Color fundus image, 1932x1932
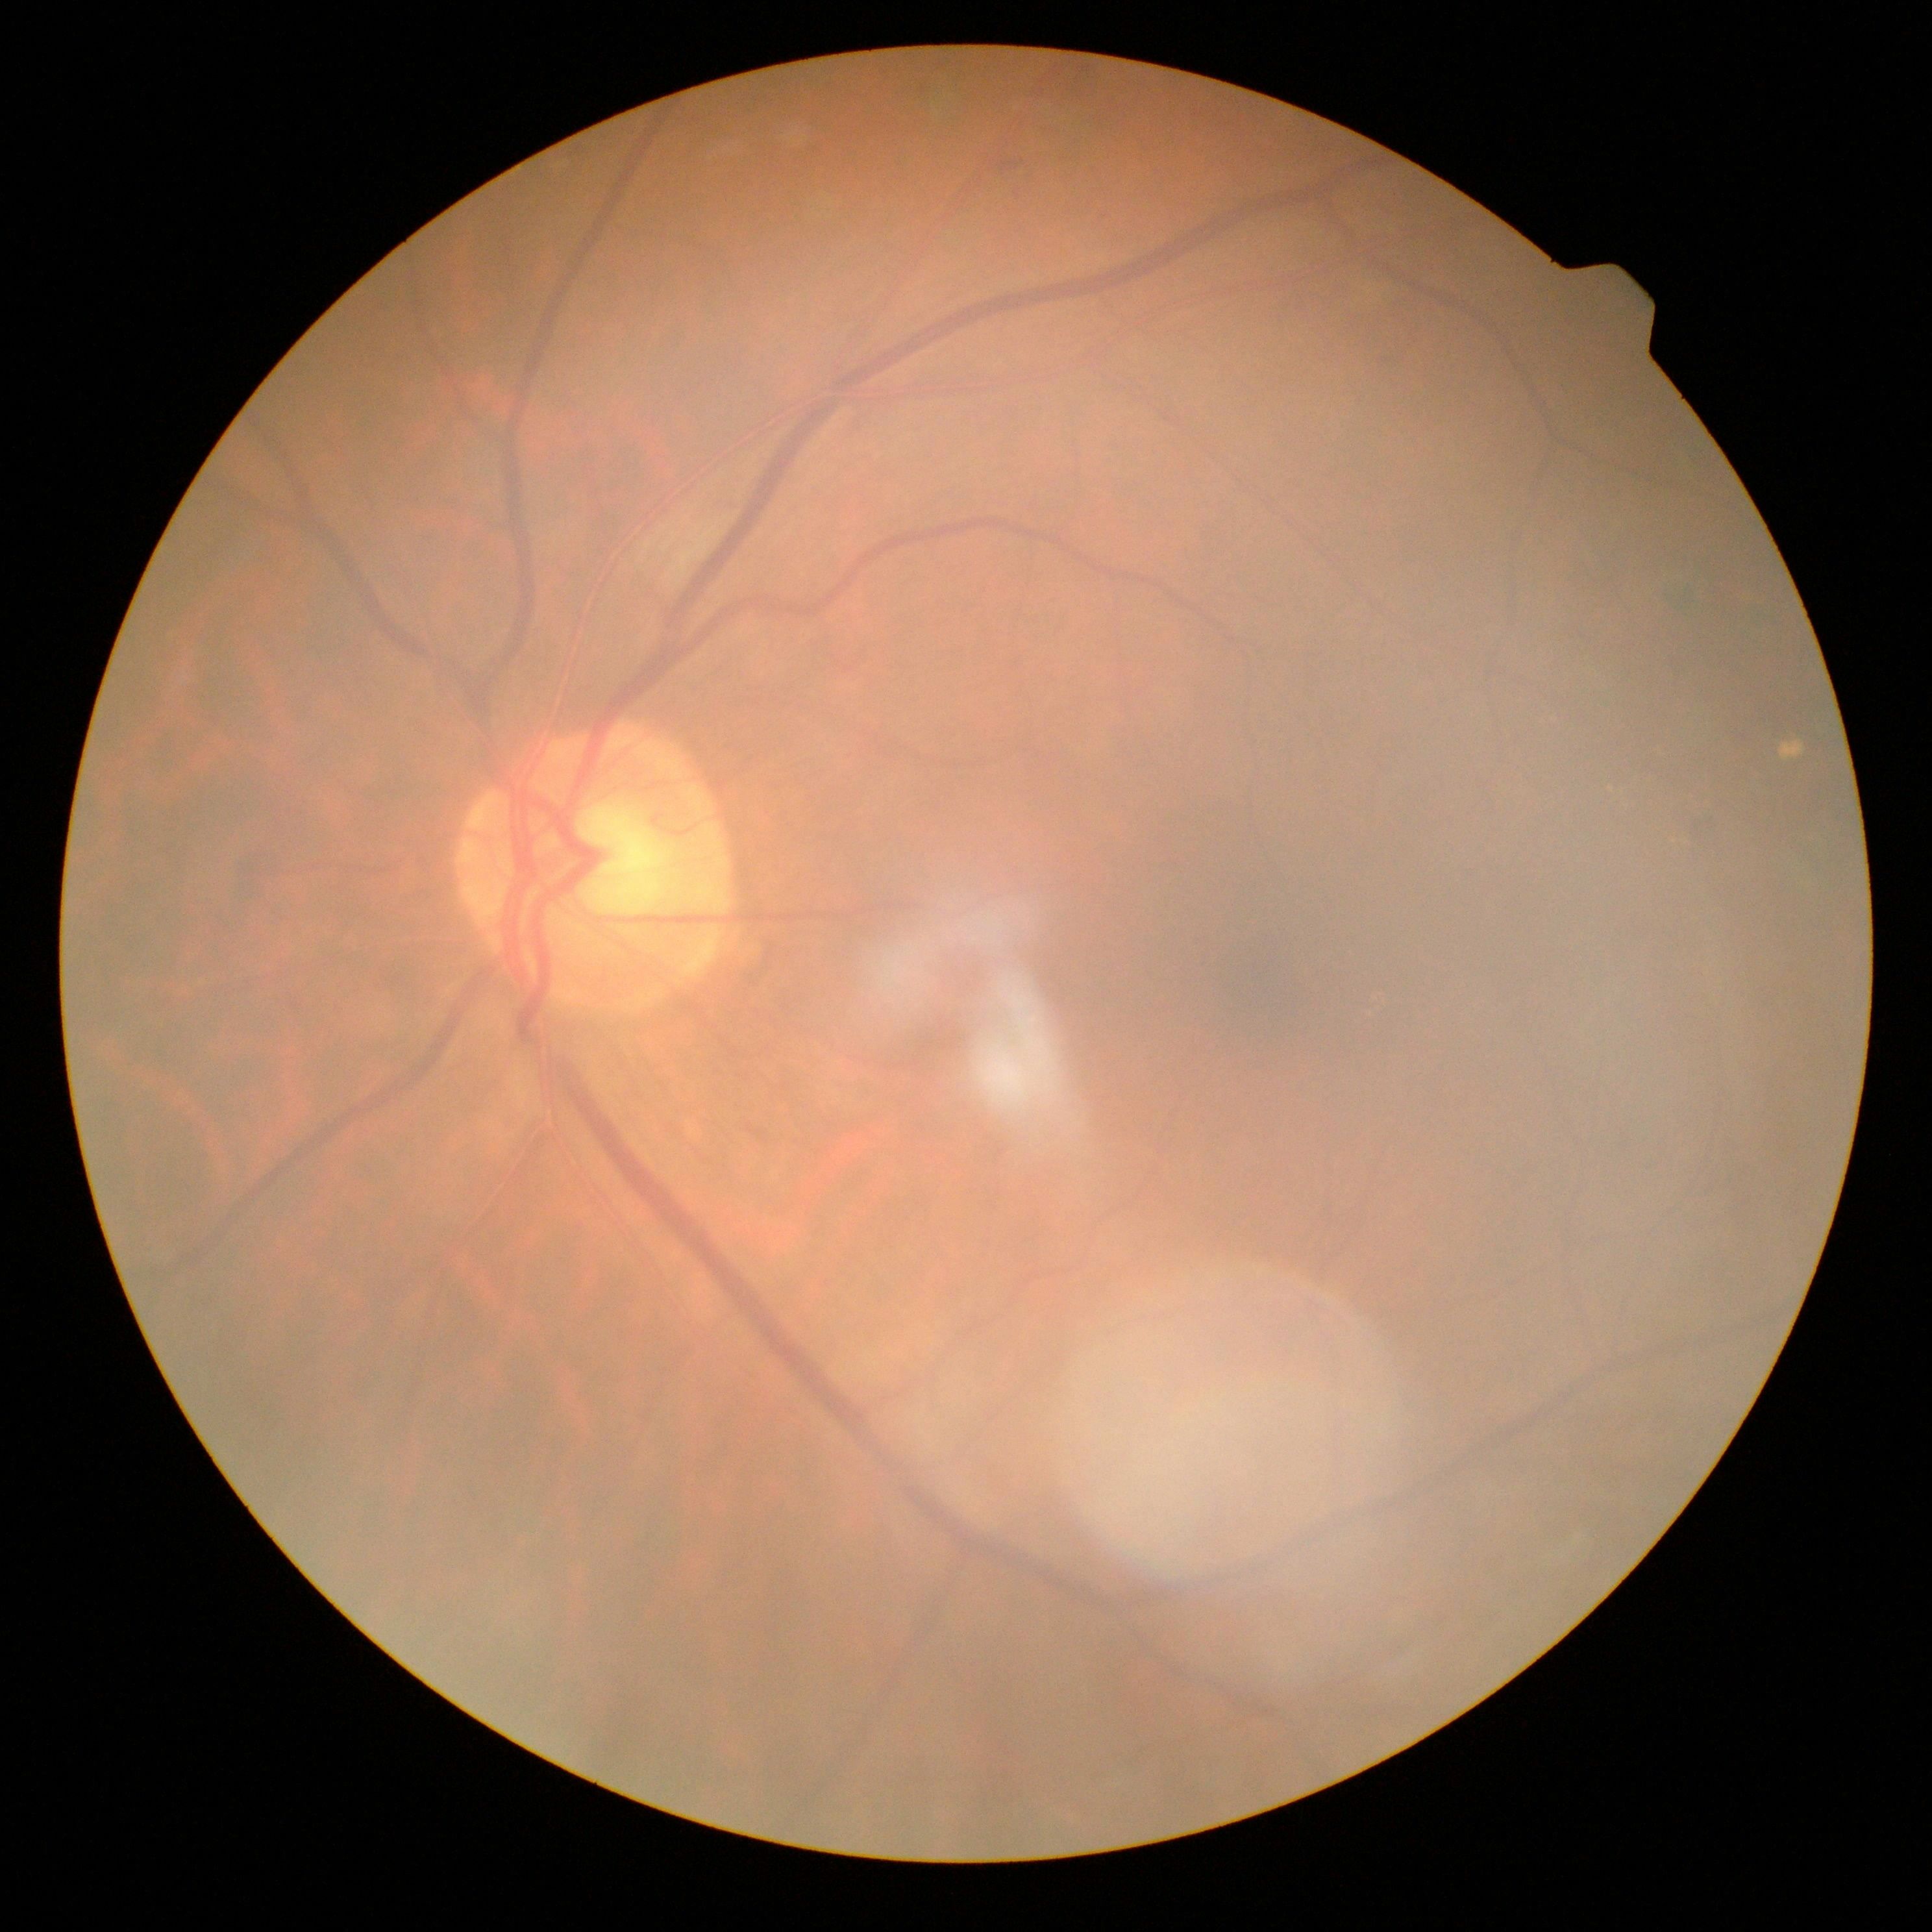
Diabetic retinopathy severity is 2.